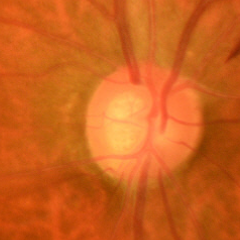
Glaucoma diagnosis: early glaucoma.